1240x1240px; wide-field fundus image from infant ROP screening; 100° field of view (Phoenix ICON) — 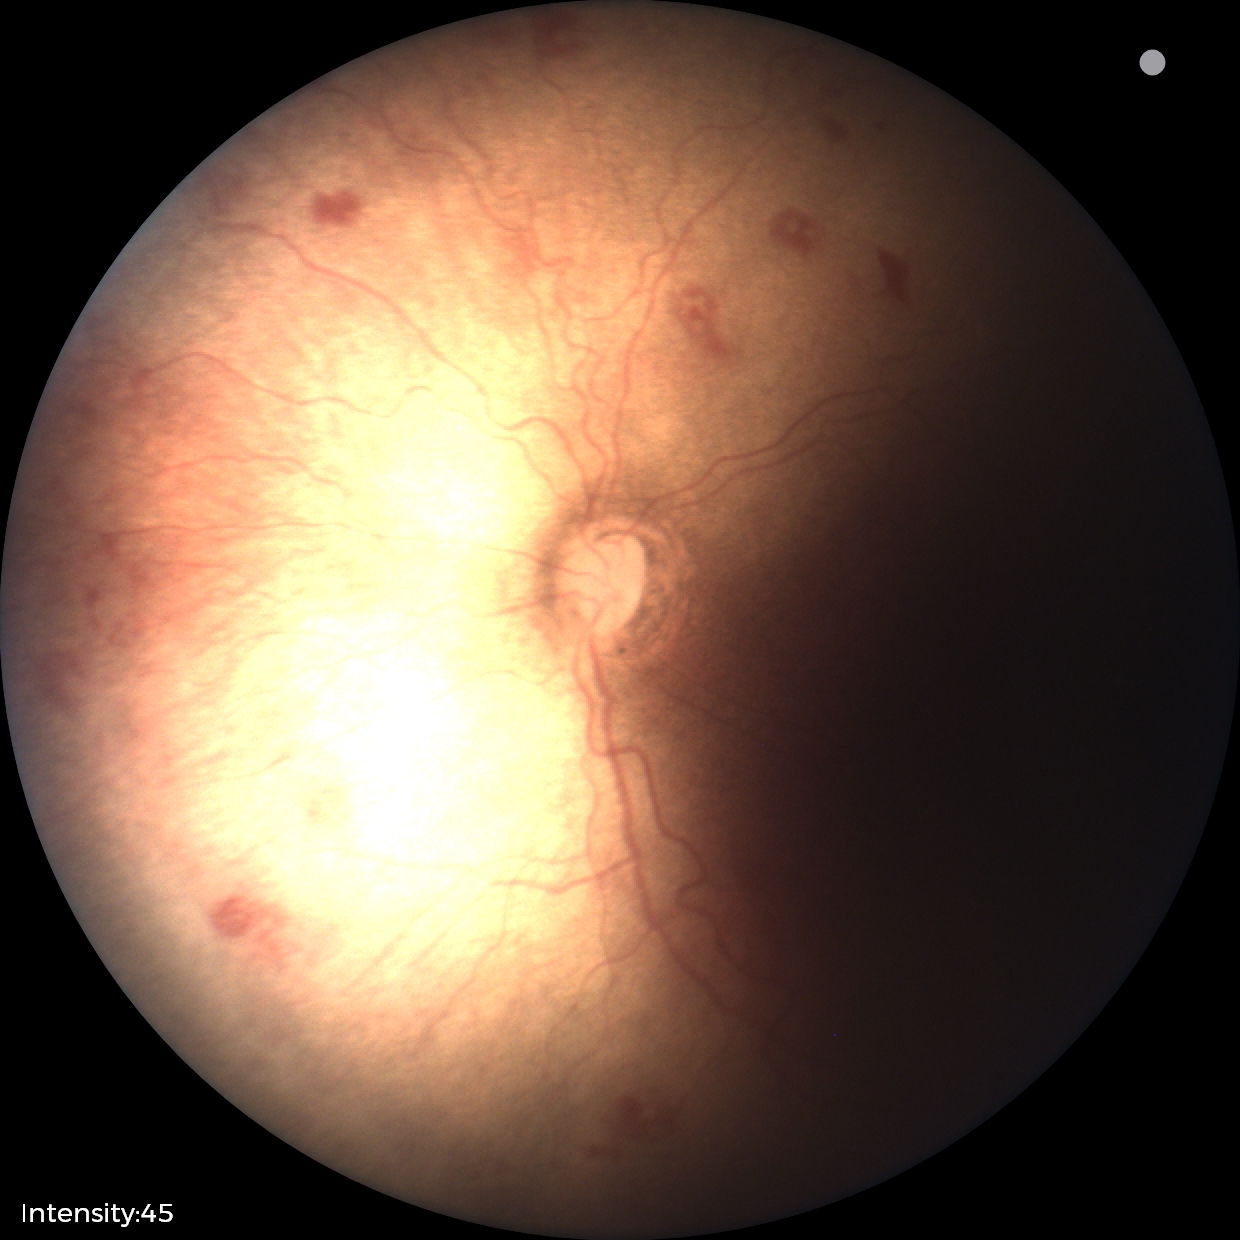 Screening diagnosis: retinopathy of prematurity stage 1.